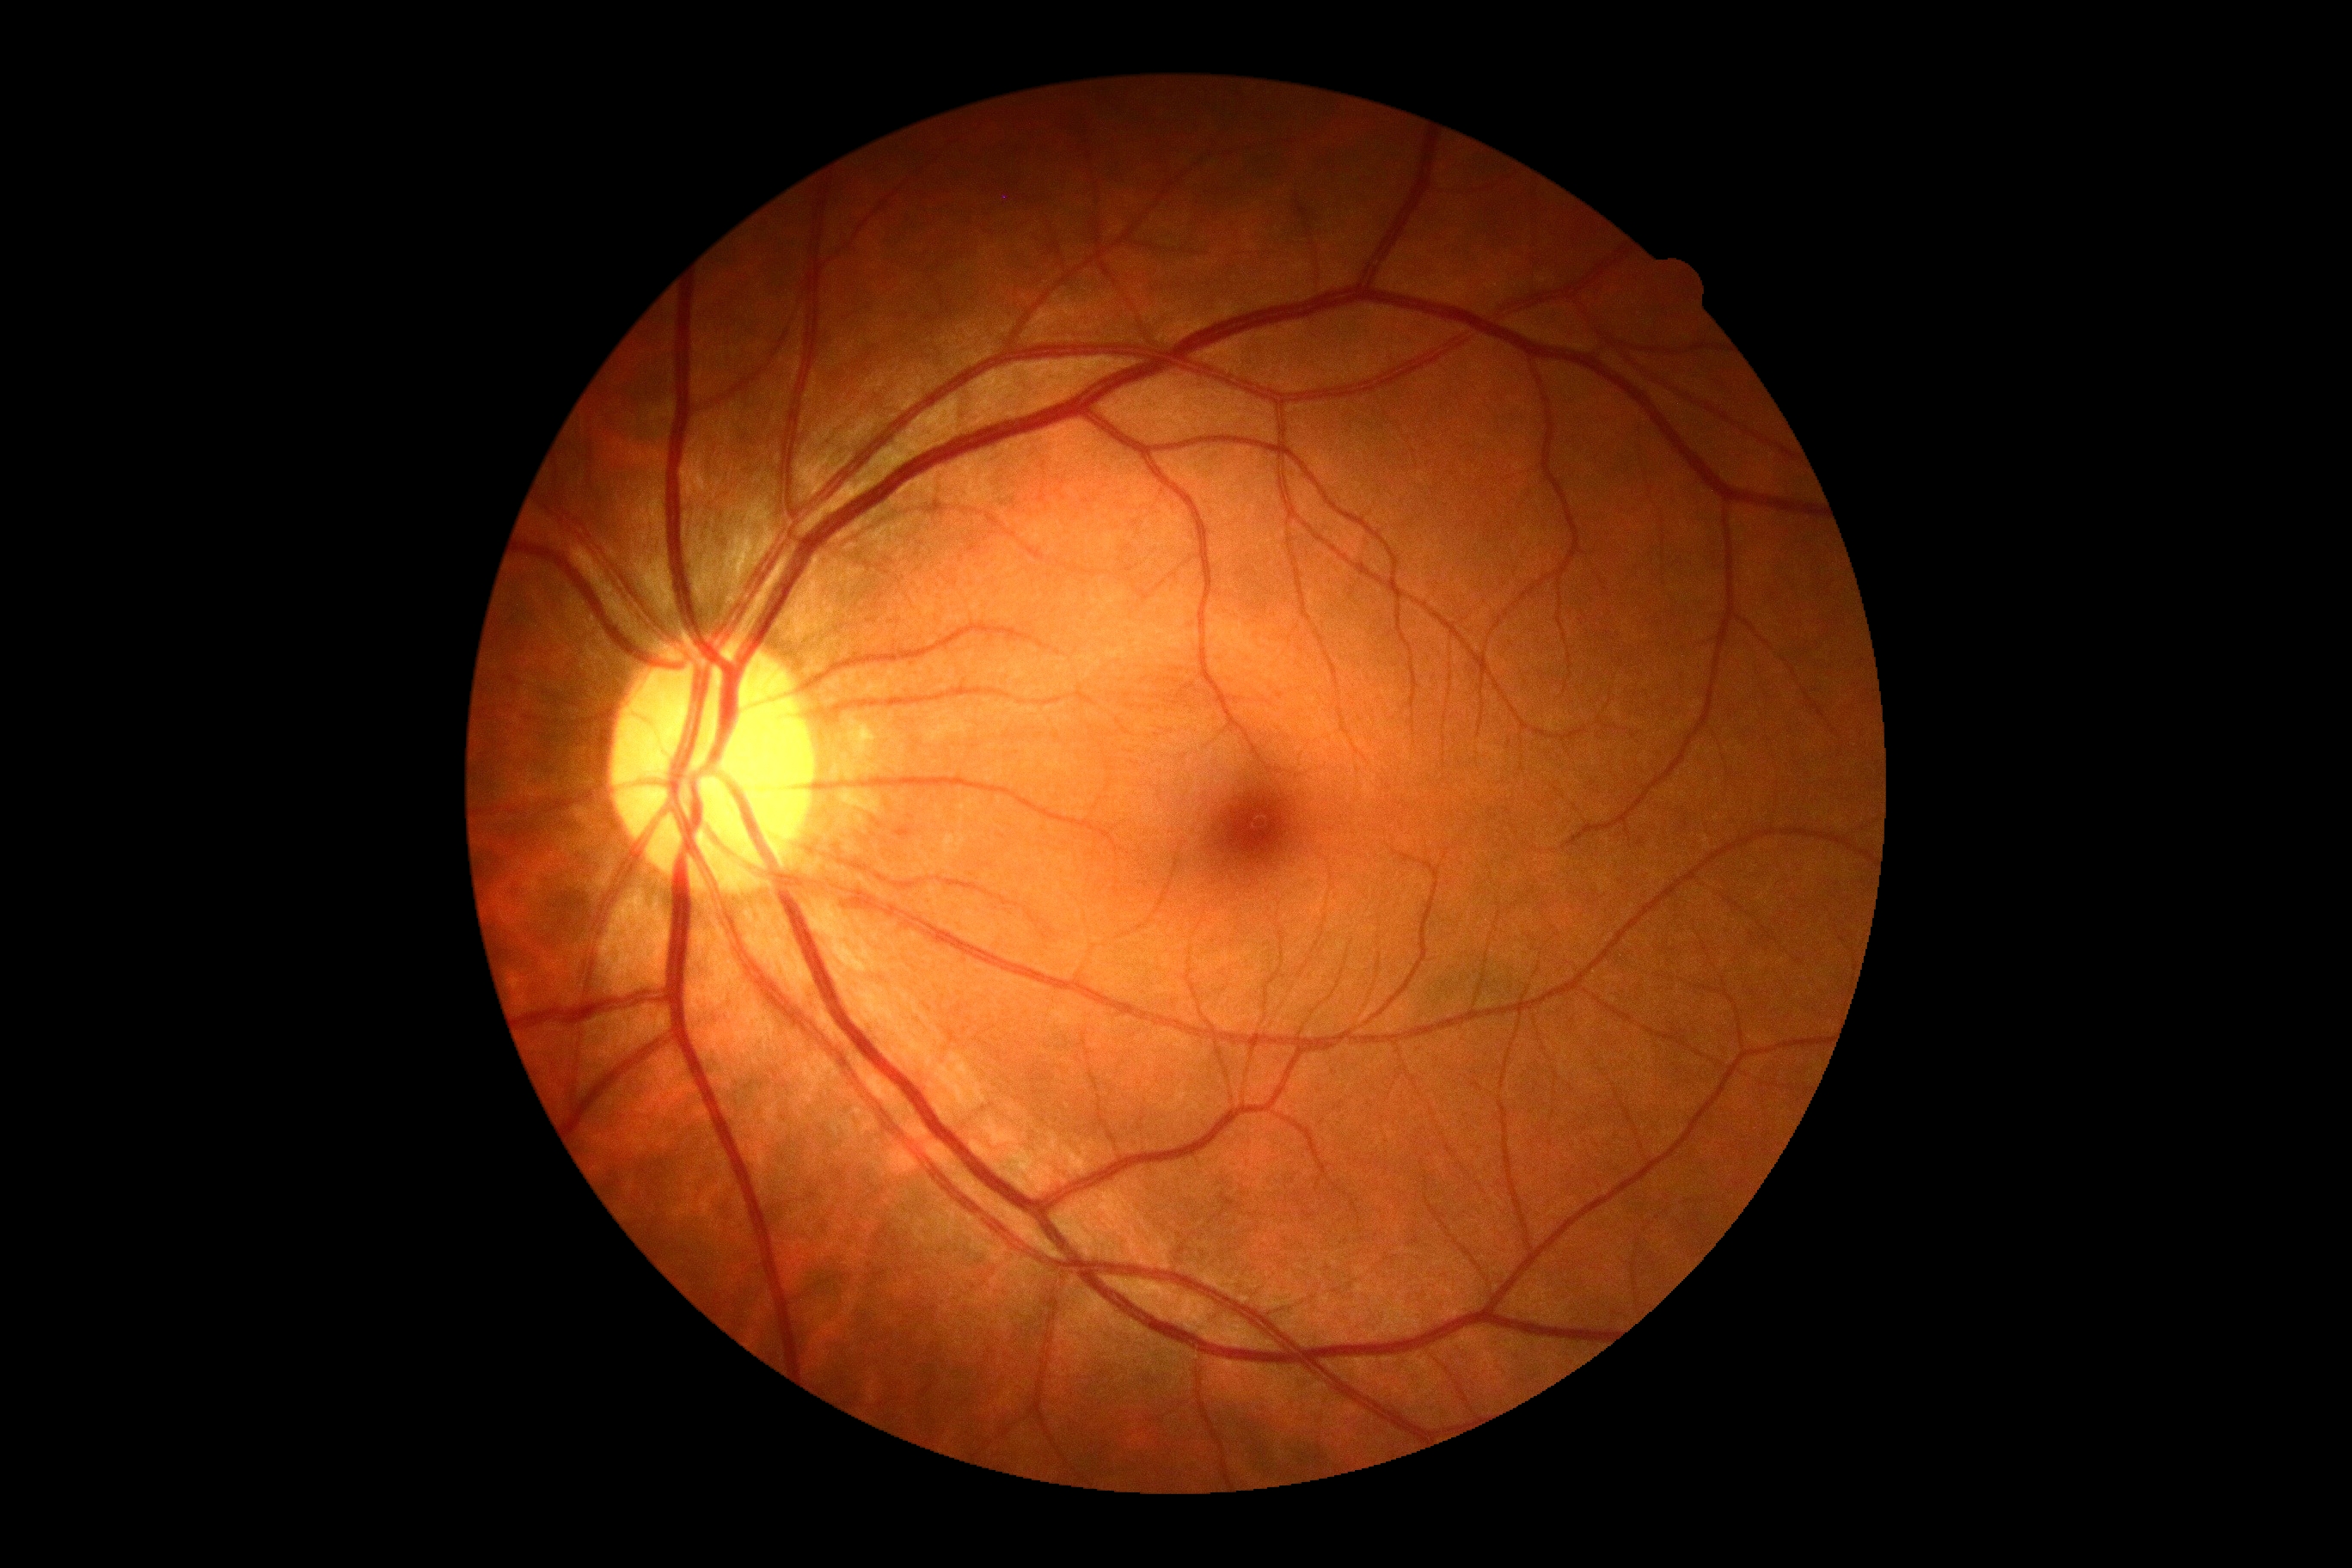 DR severity: grade 0 (no apparent retinopathy).